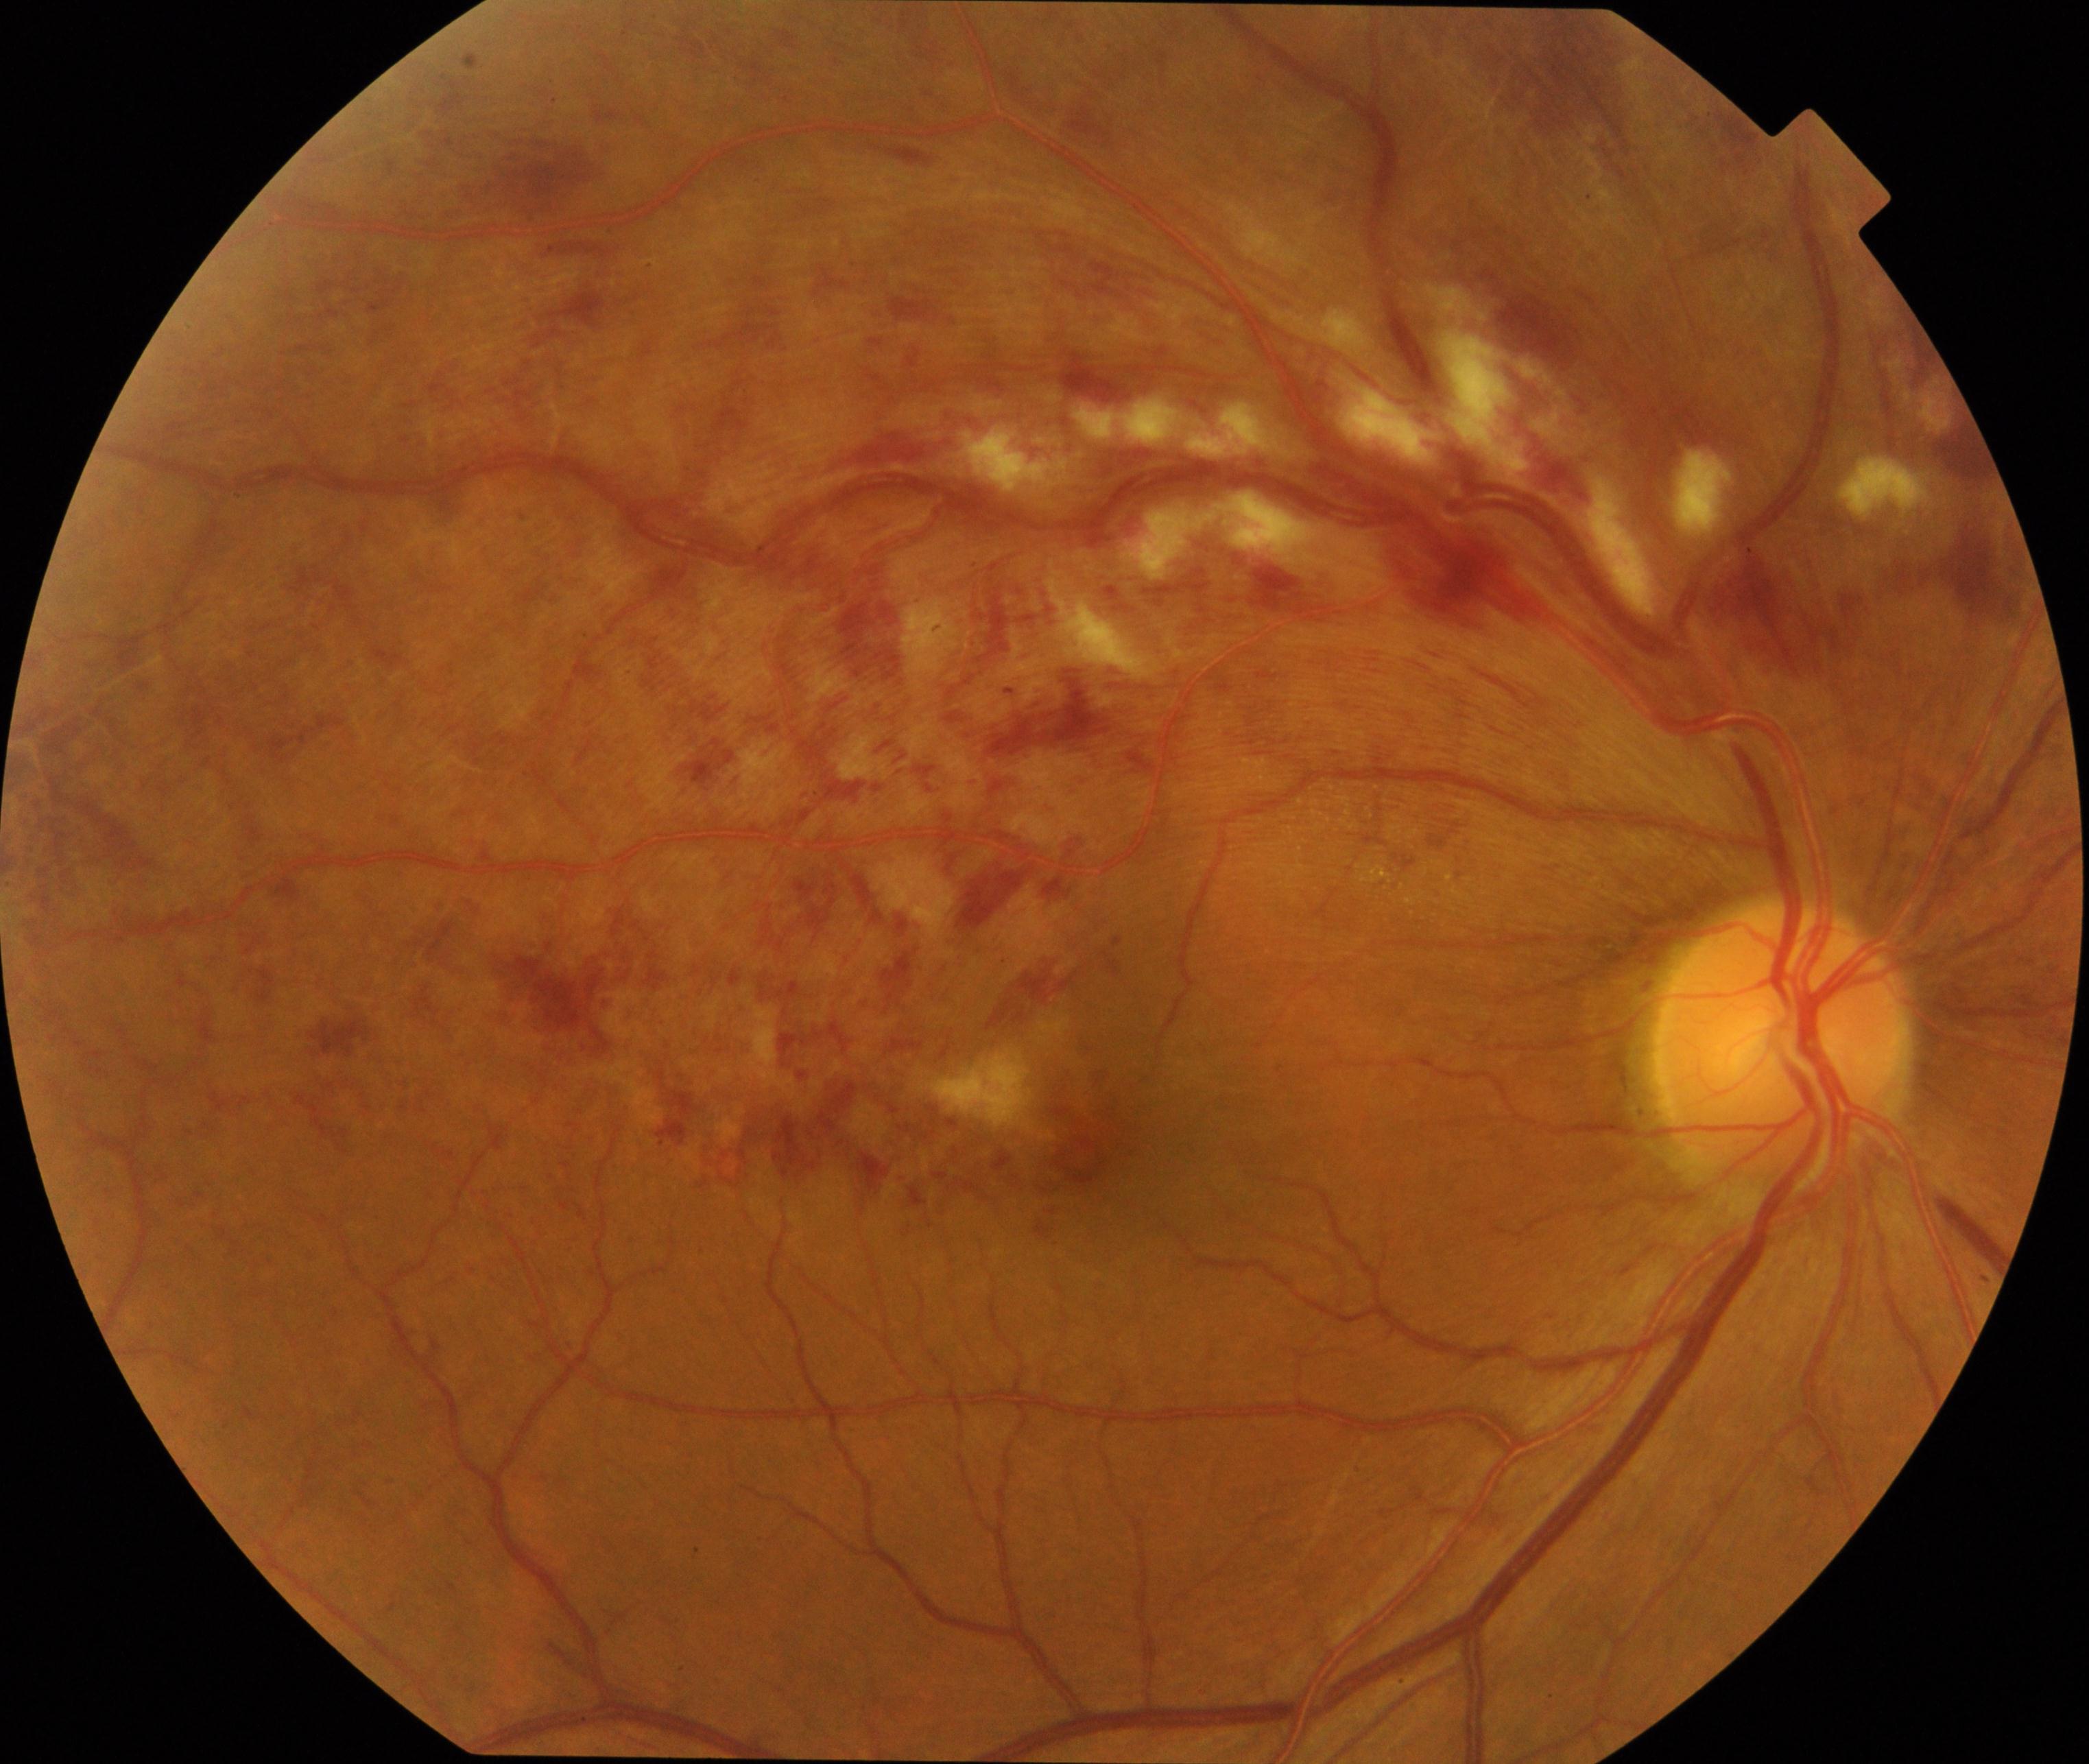
Findings: branch retinal vein occlusion.